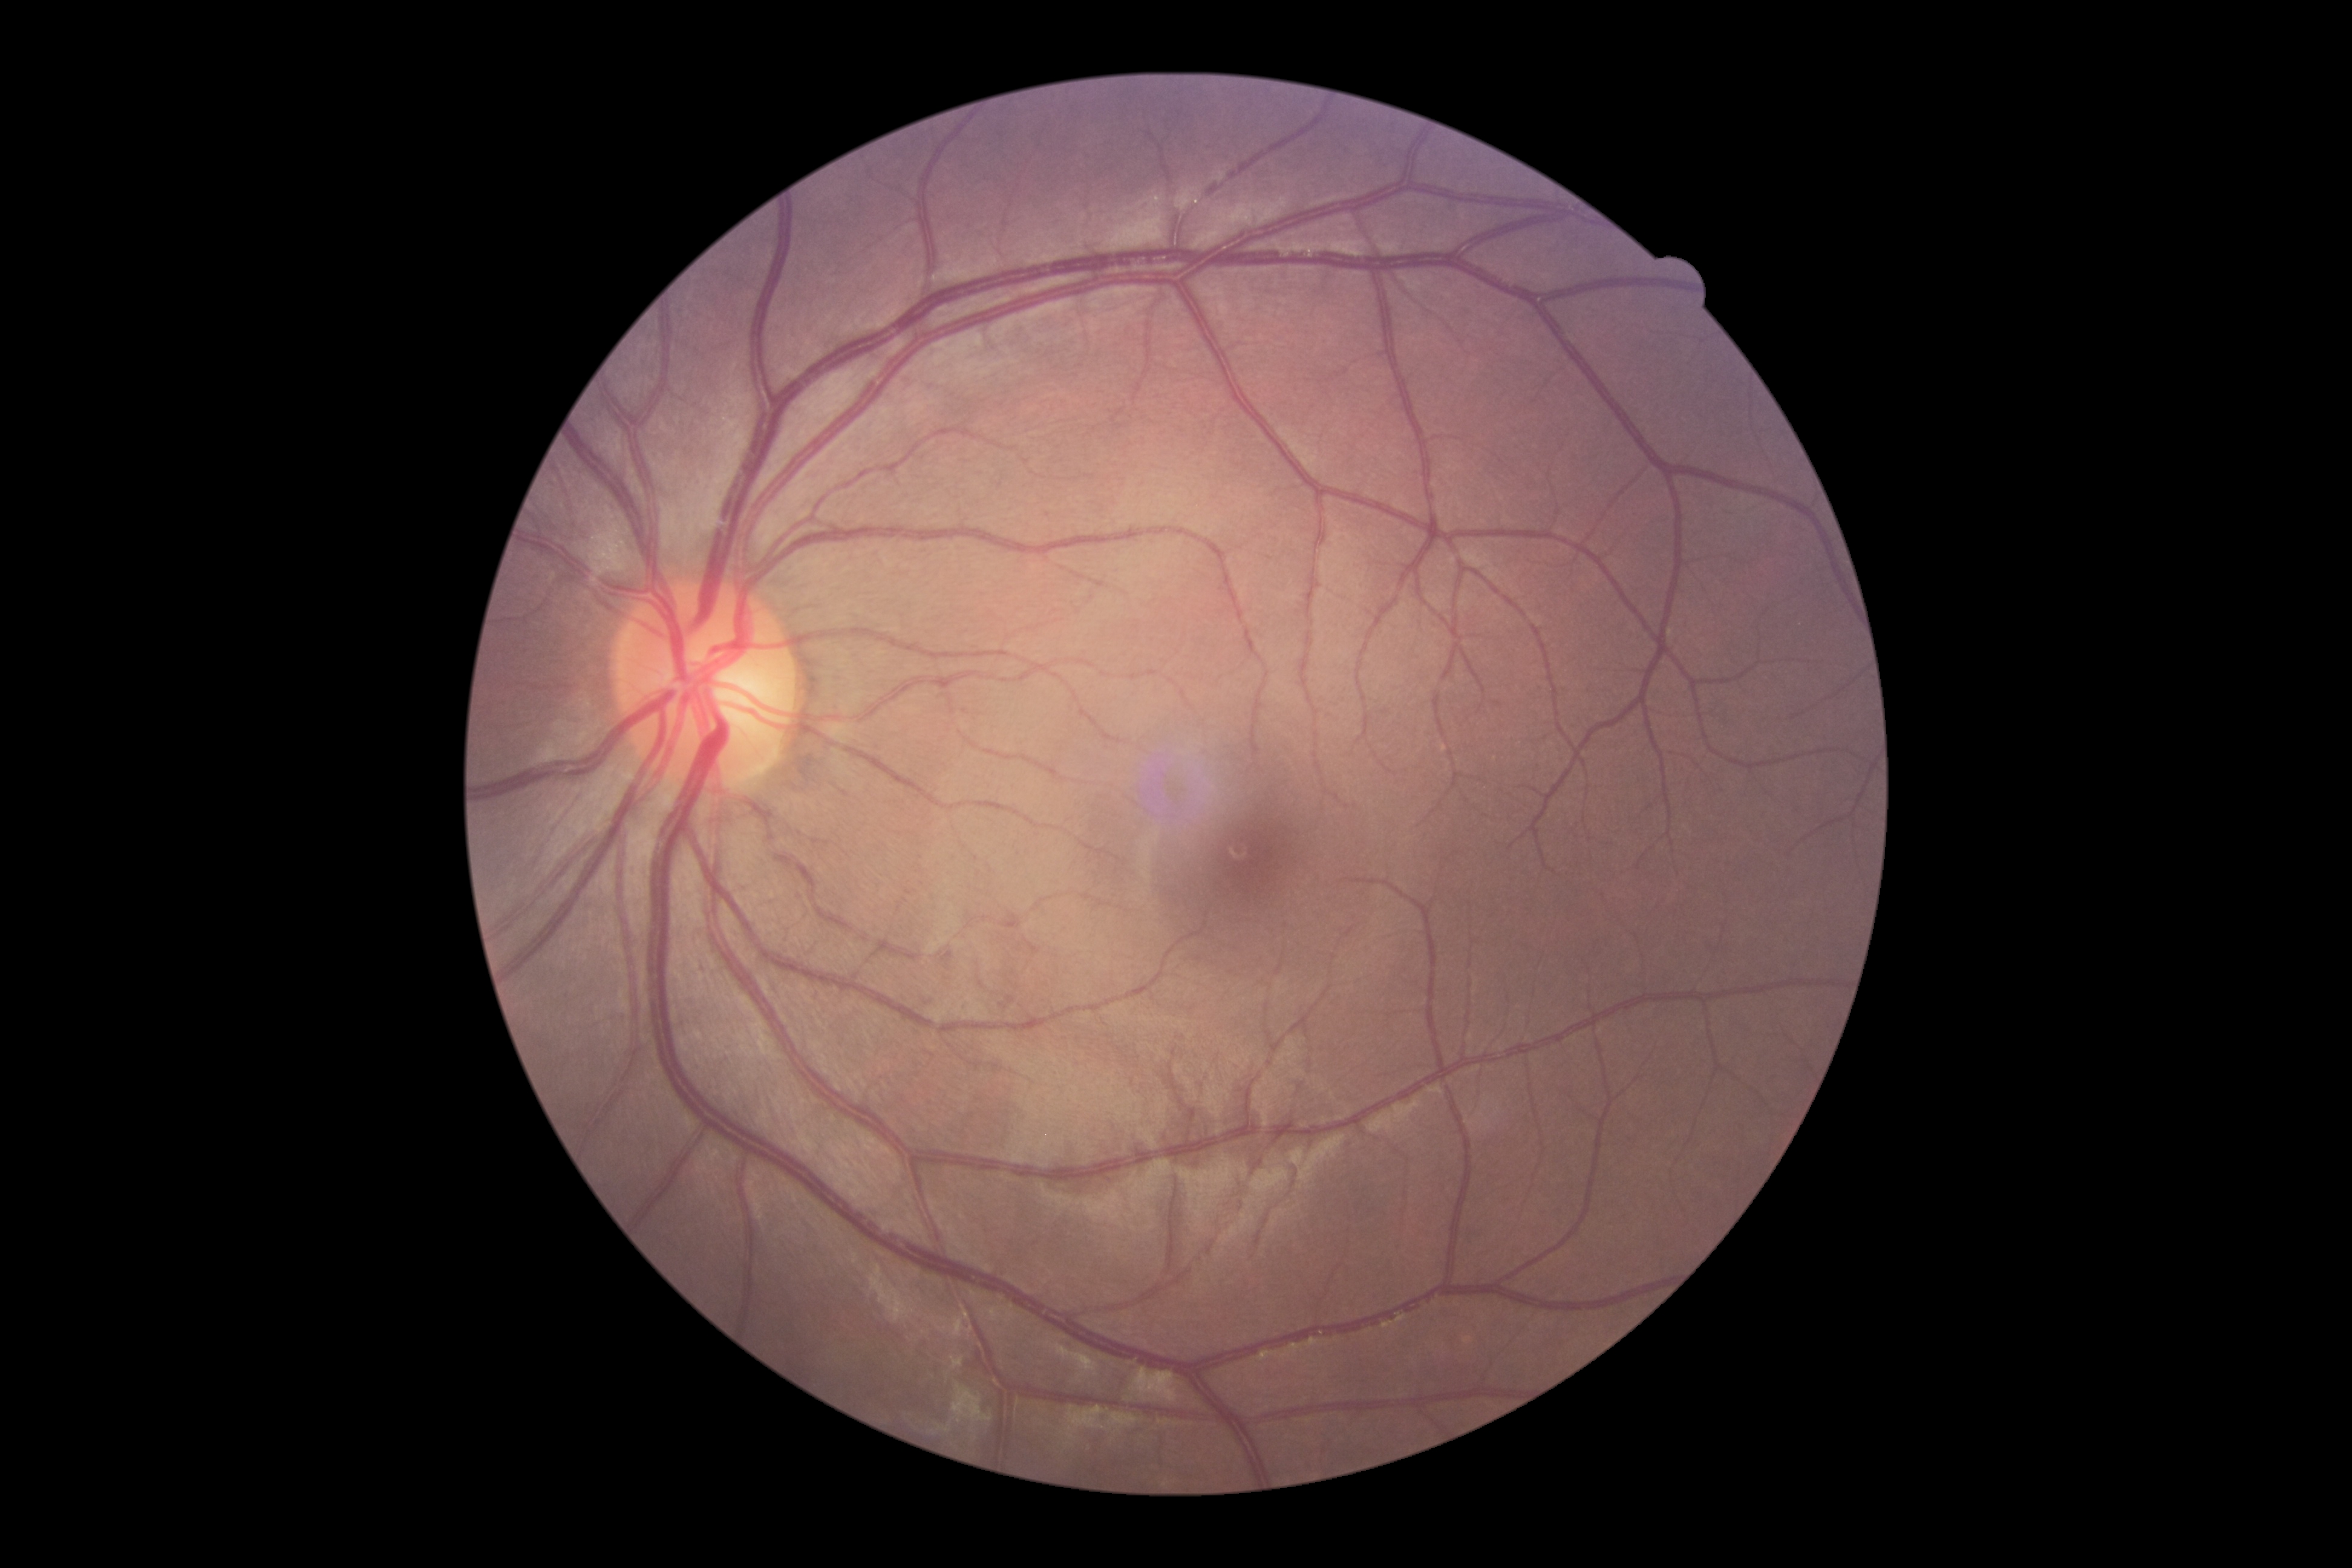 DR = no apparent retinopathy (grade 0).